Wide-field contact fundus photograph of an infant: 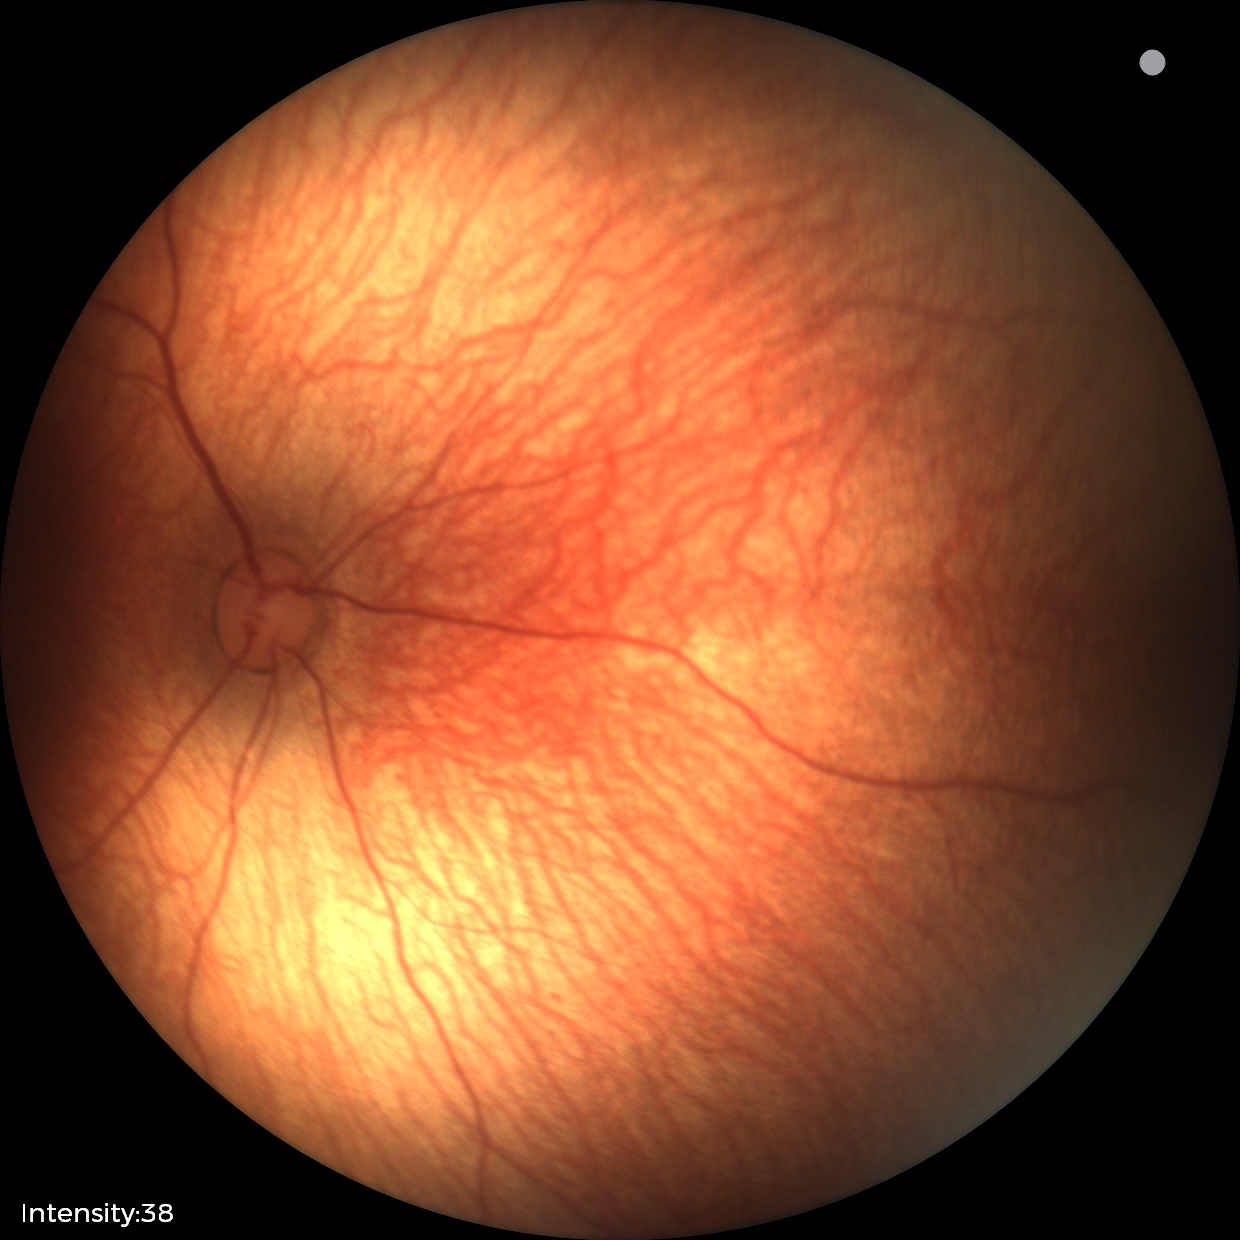 Normal screening examination.